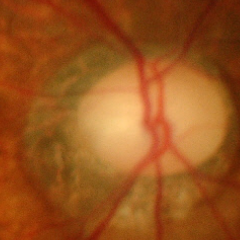
Q: Does this eye have glaucoma?
A: Yes — advanced glaucoma.